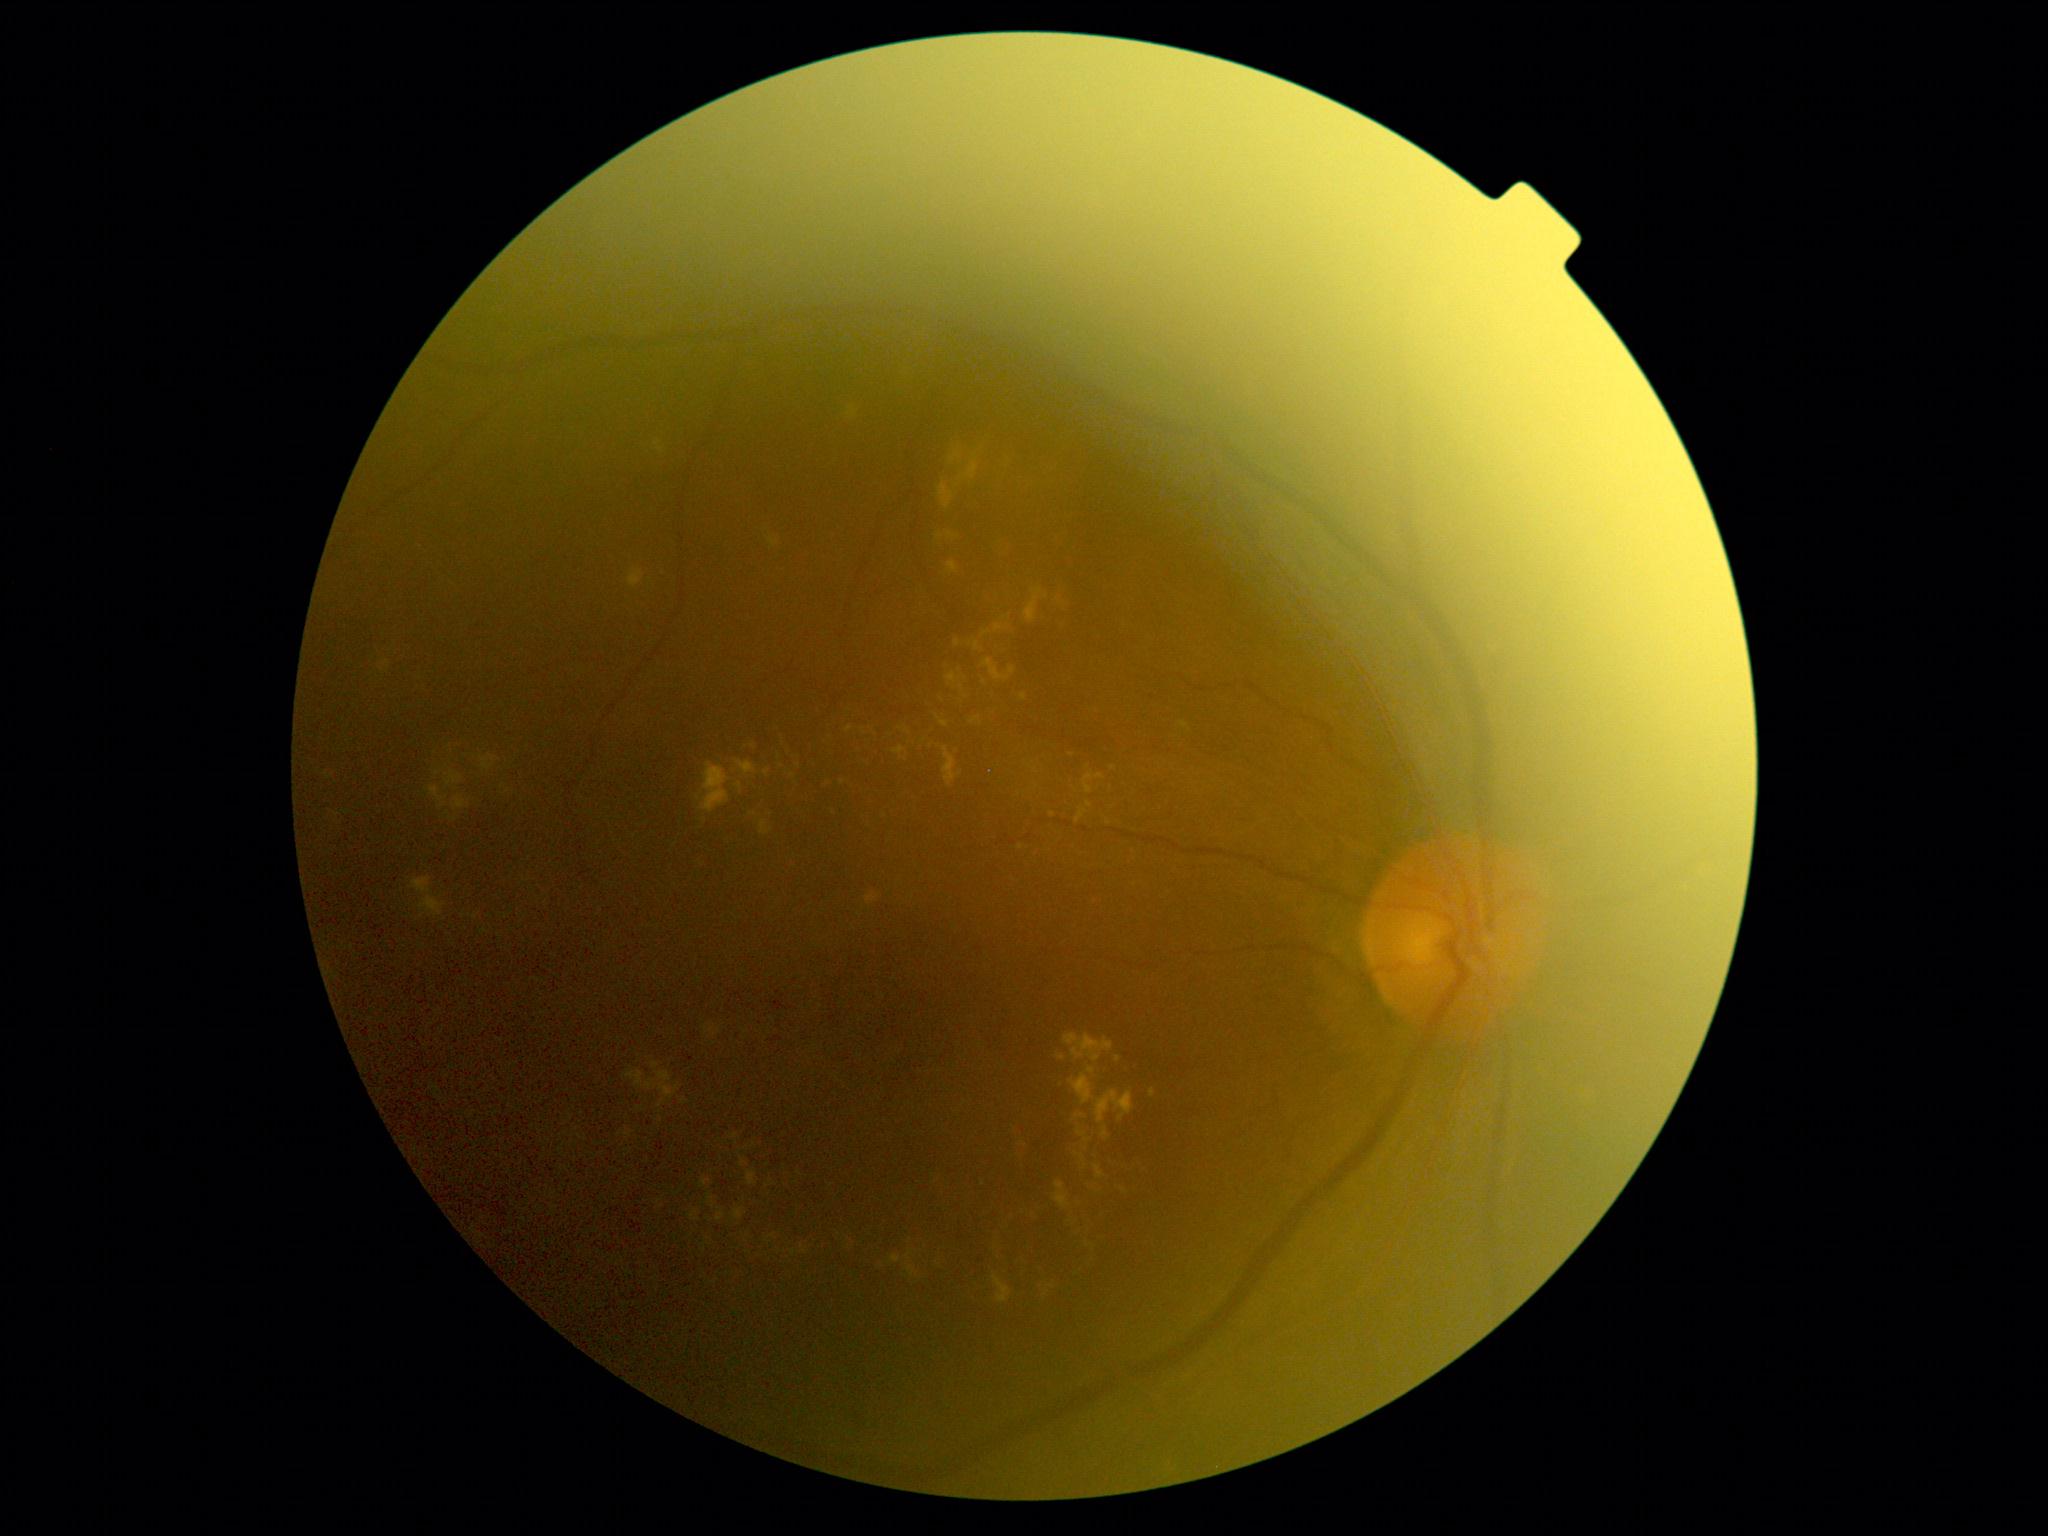

Diabetic retinopathy (DR): grade 2 (moderate NPDR) — more than just microaneurysms but less than severe NPDR
Lesions identified (partial list):
hard exudates (EXs) (partial): bbox=(1069, 1211, 1095, 1263); bbox=(816, 779, 827, 786); bbox=(943, 747, 962, 787); bbox=(1074, 1114, 1088, 1121); bbox=(774, 733, 792, 761); bbox=(1150, 1089, 1155, 1098); bbox=(1077, 1128, 1091, 1143); bbox=(906, 1264, 919, 1277); bbox=(452, 795, 471, 812); bbox=(982, 631, 991, 637); bbox=(941, 721, 949, 729); bbox=(846, 1233, 855, 1250); bbox=(1101, 1127, 1110, 1140)
Small EXs near <point>931, 747</point>; <point>453, 819</point>; <point>970, 645</point>; <point>1135, 886</point>; <point>1053, 1288</point>; <point>660, 1202</point>; <point>1021, 847</point>